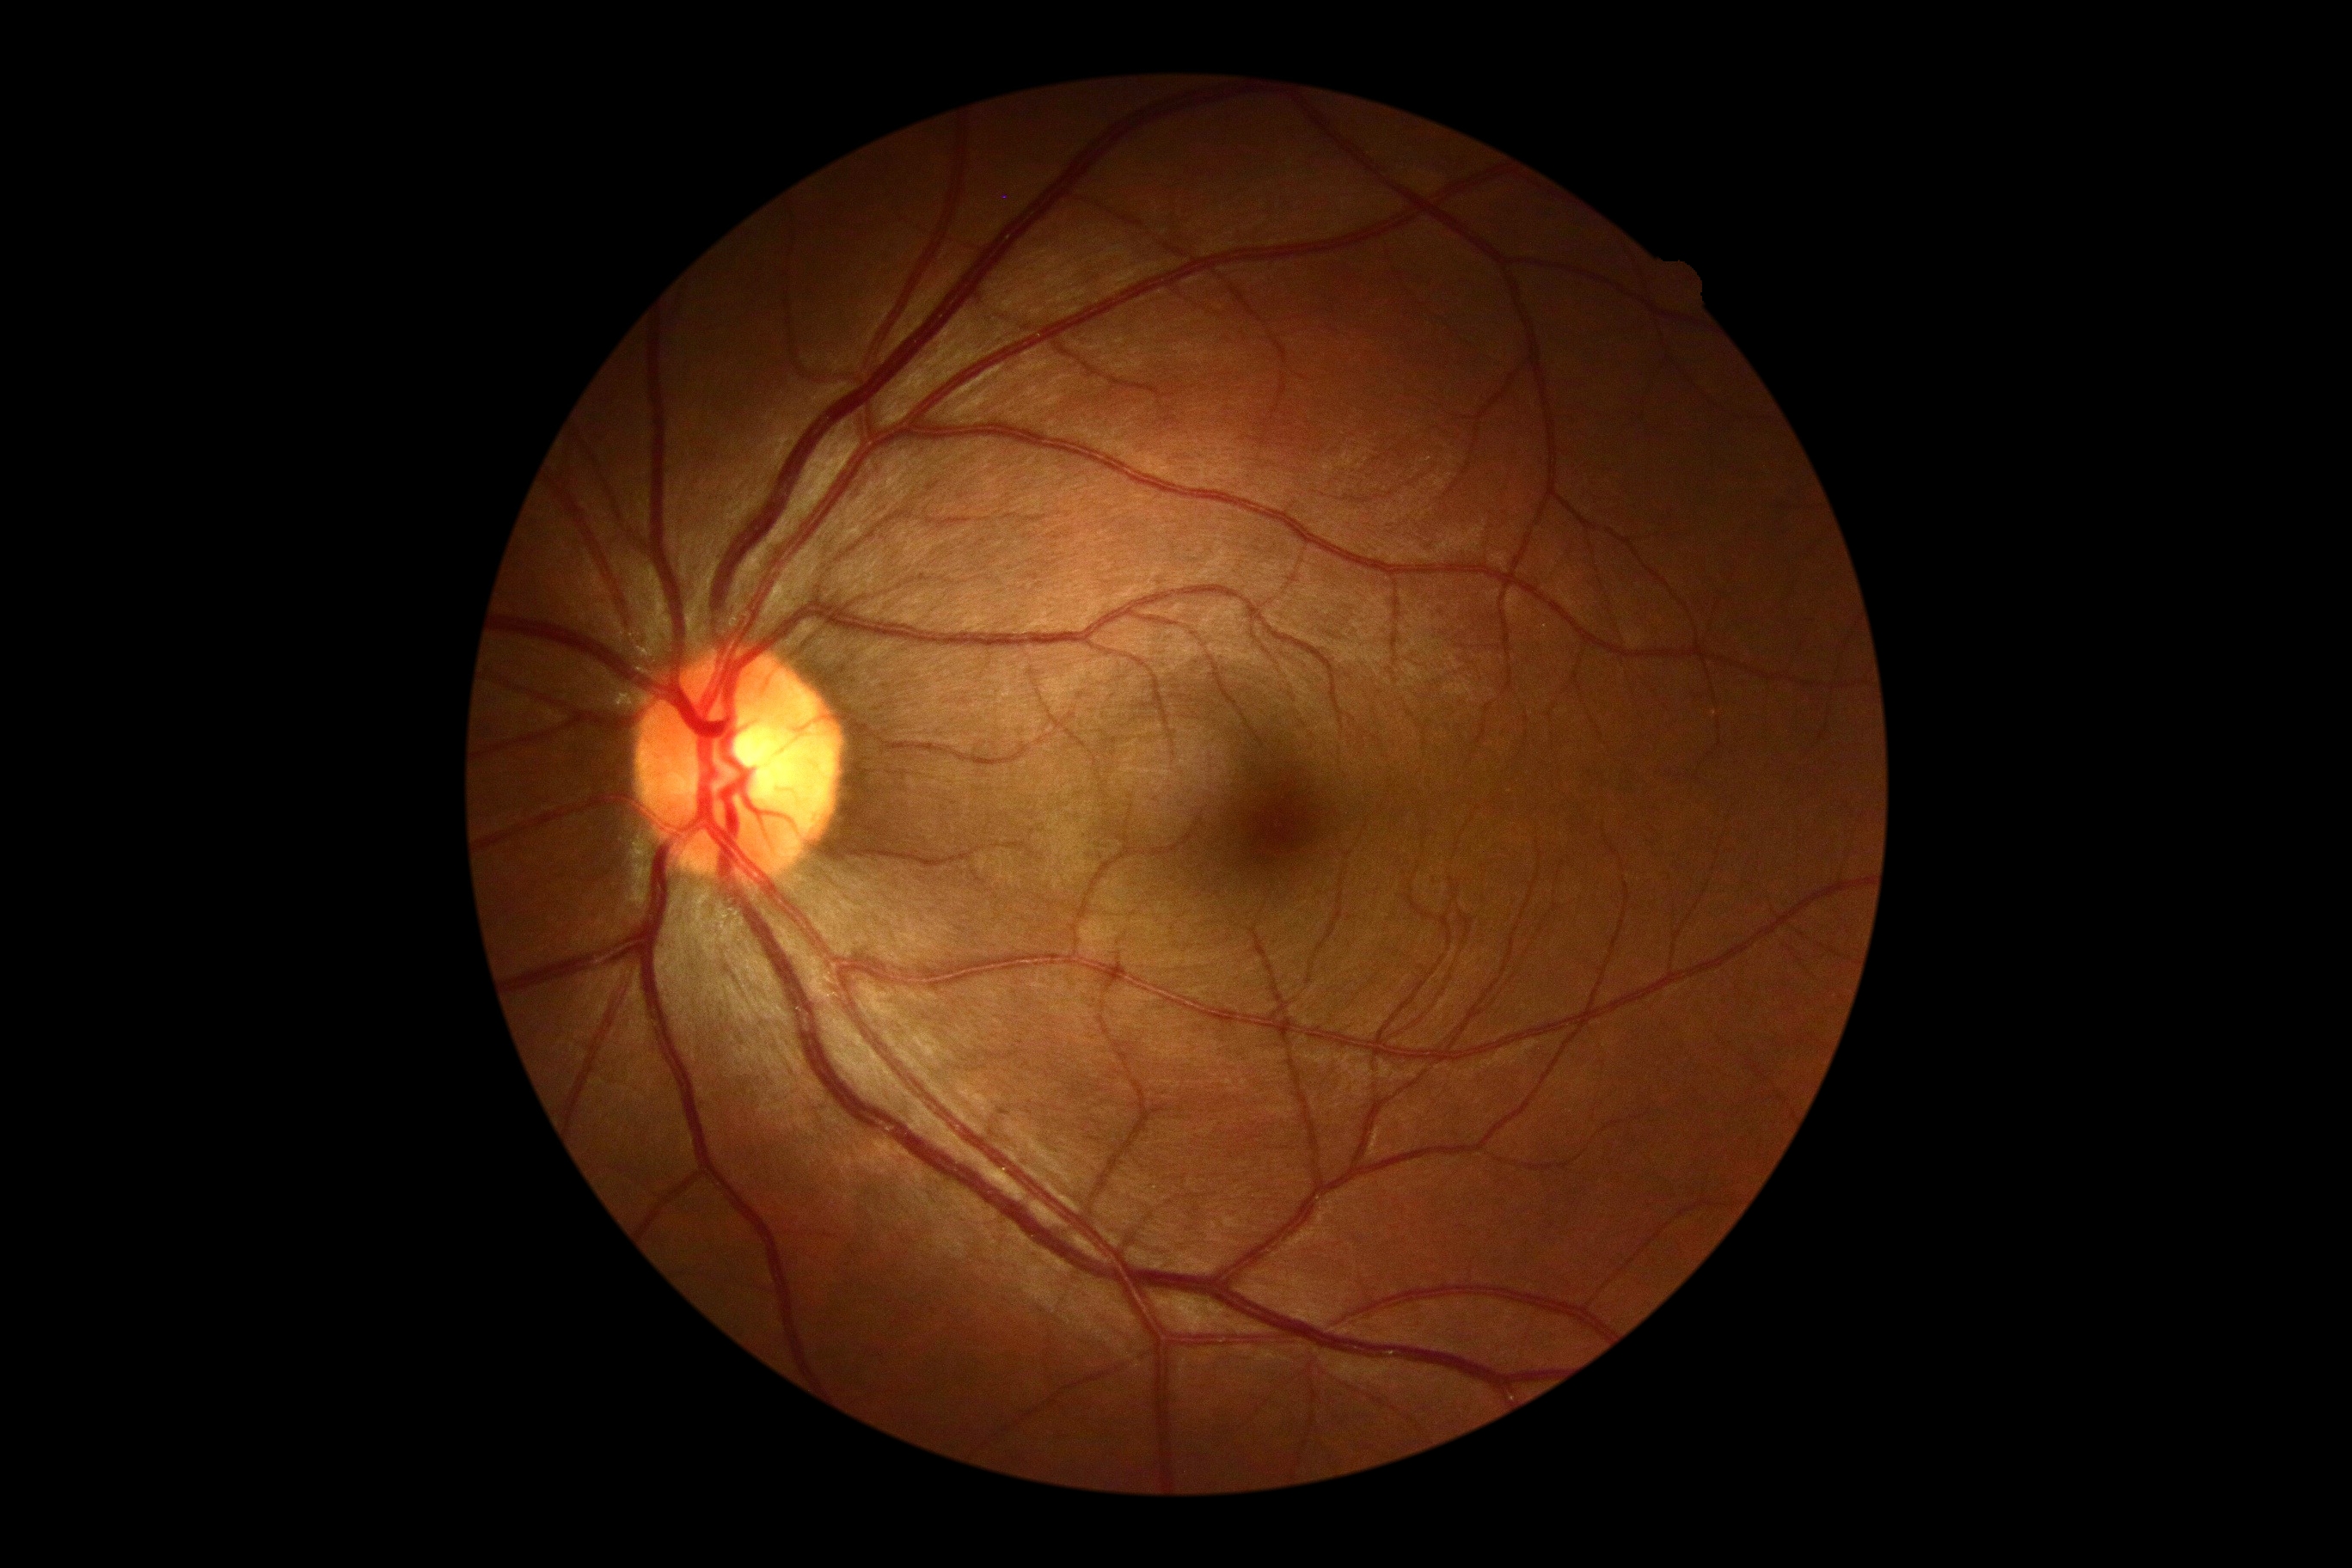
Diabetic retinopathy (DR) is grade 0.